Camera: Remidio Fundus on Phone (FOP) camera · image size 1659x2212 — 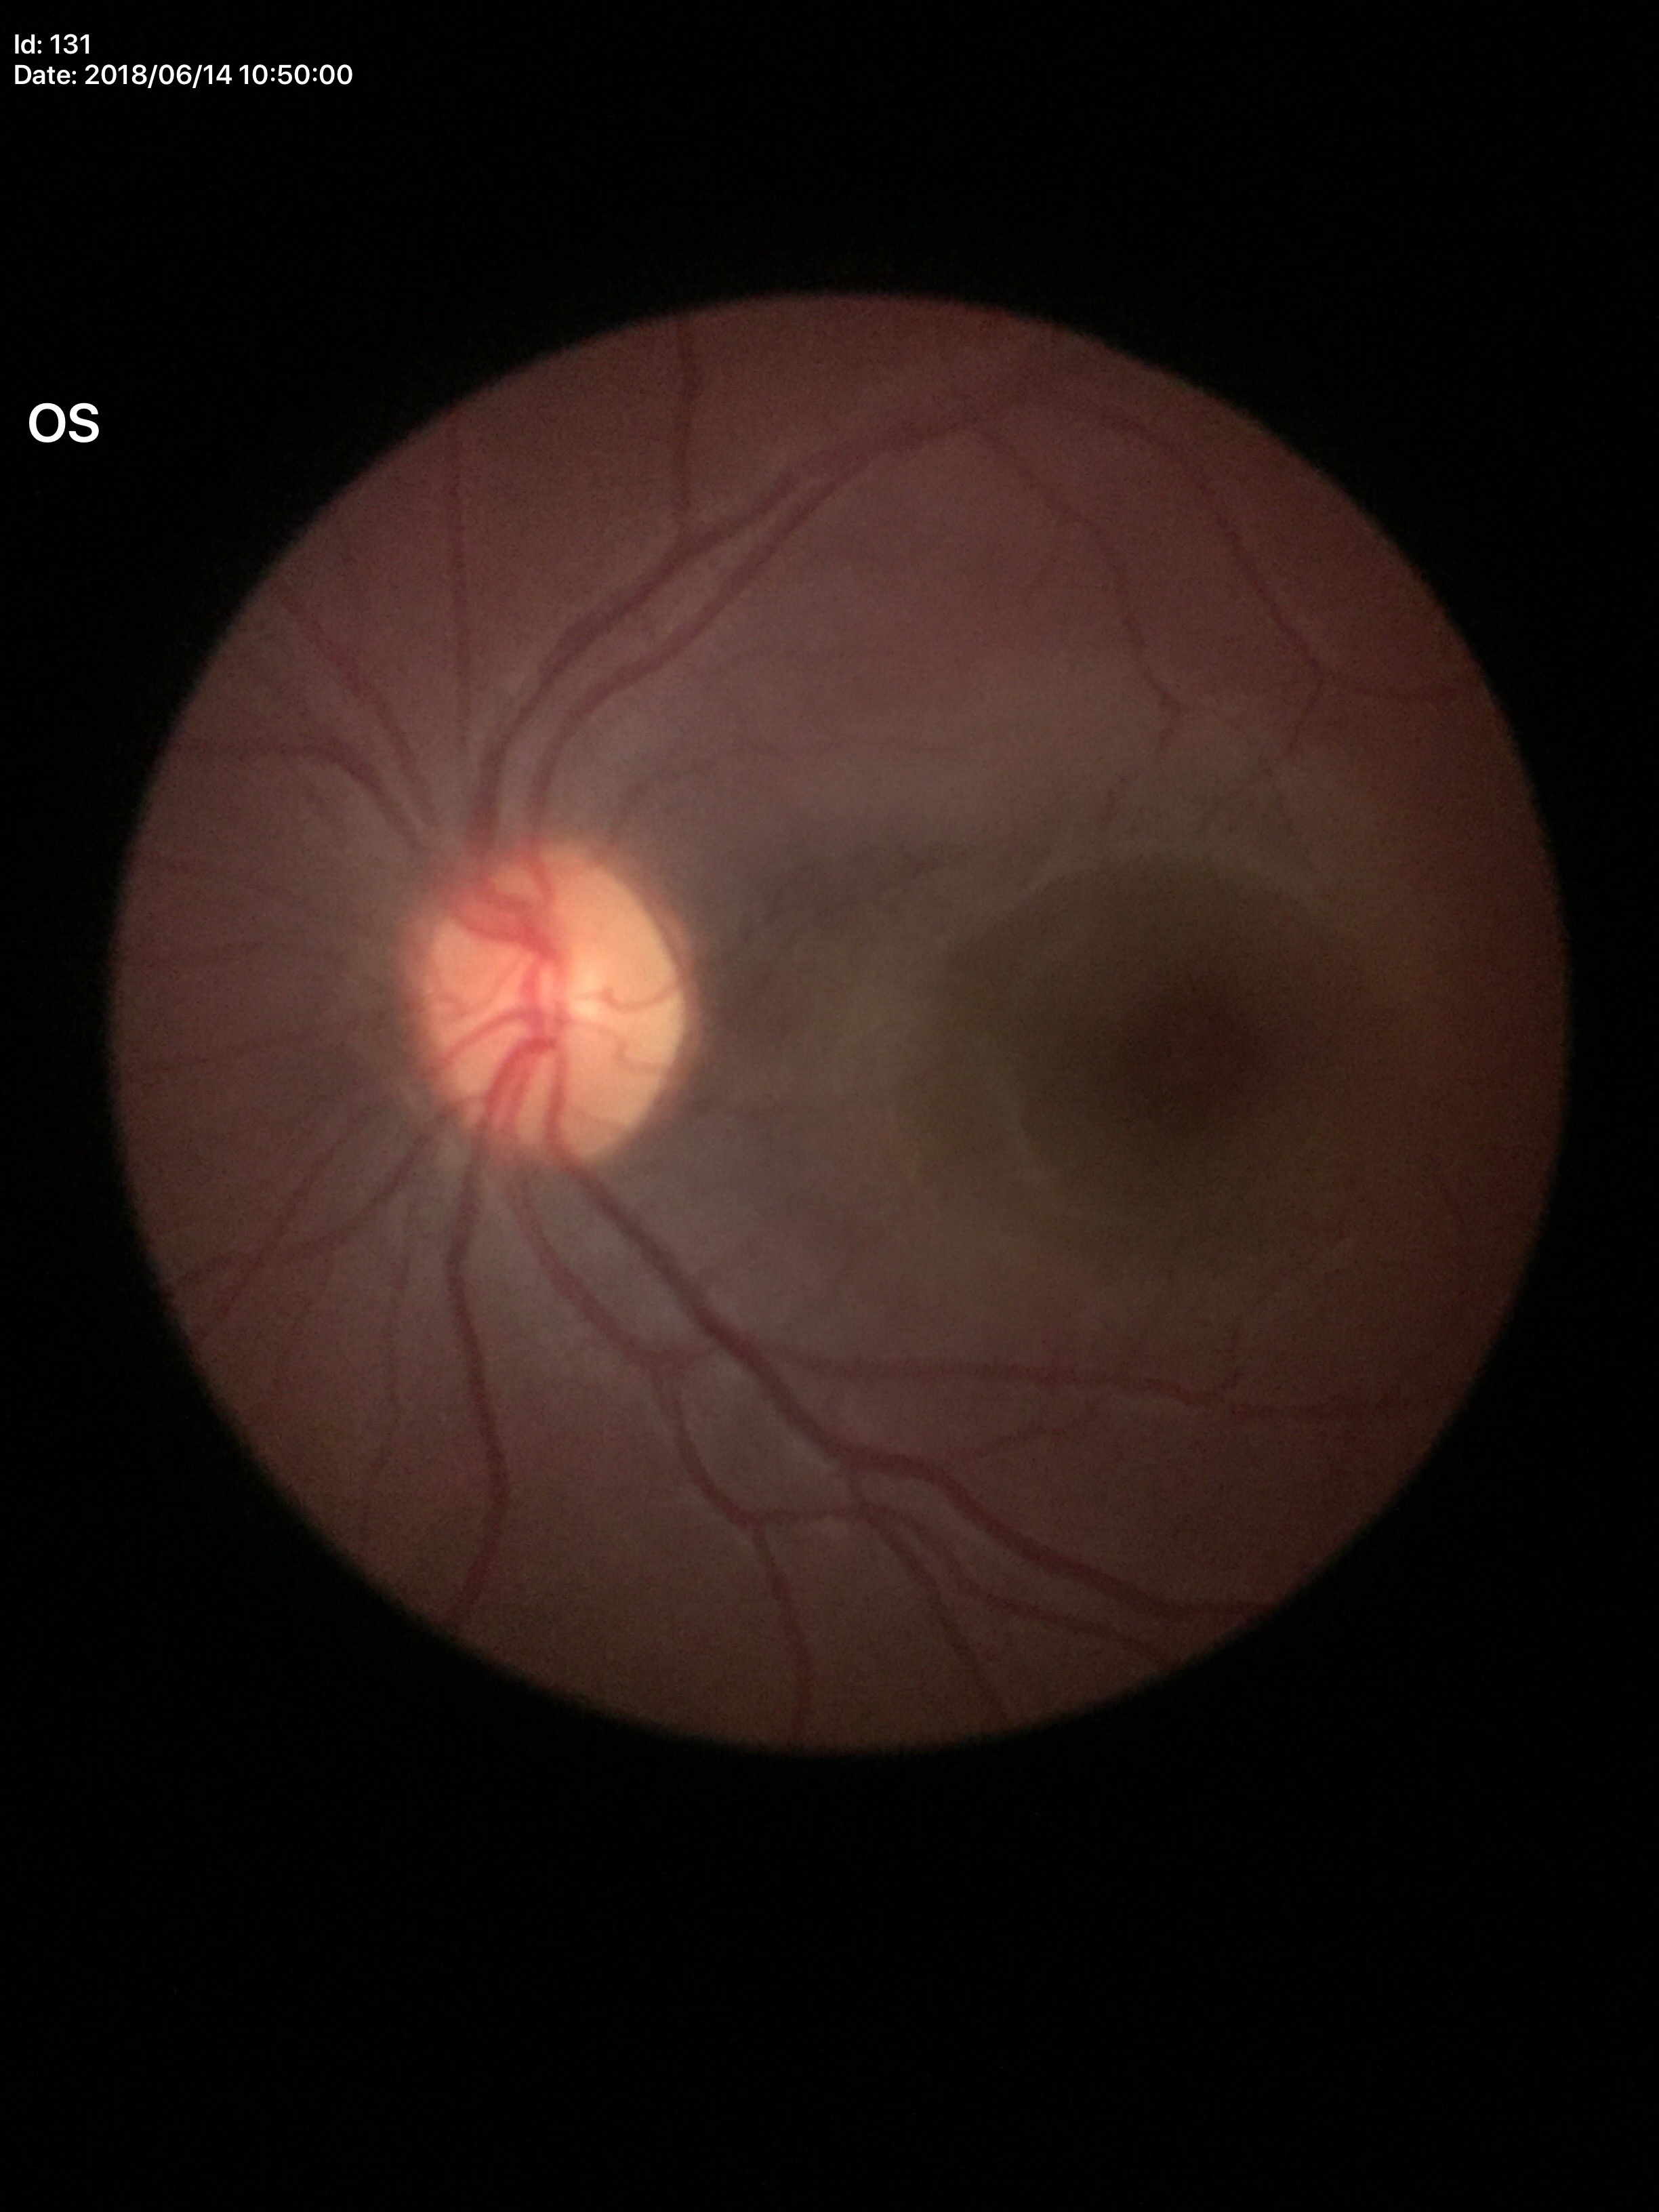
Q: Is there glaucoma suspicion?
A: negative
Q: What is the horizontal cup-to-disc ratio?
A: 0.47
Q: What is the vertical cup-to-disc ratio?
A: 0.43